45-degree field of view — 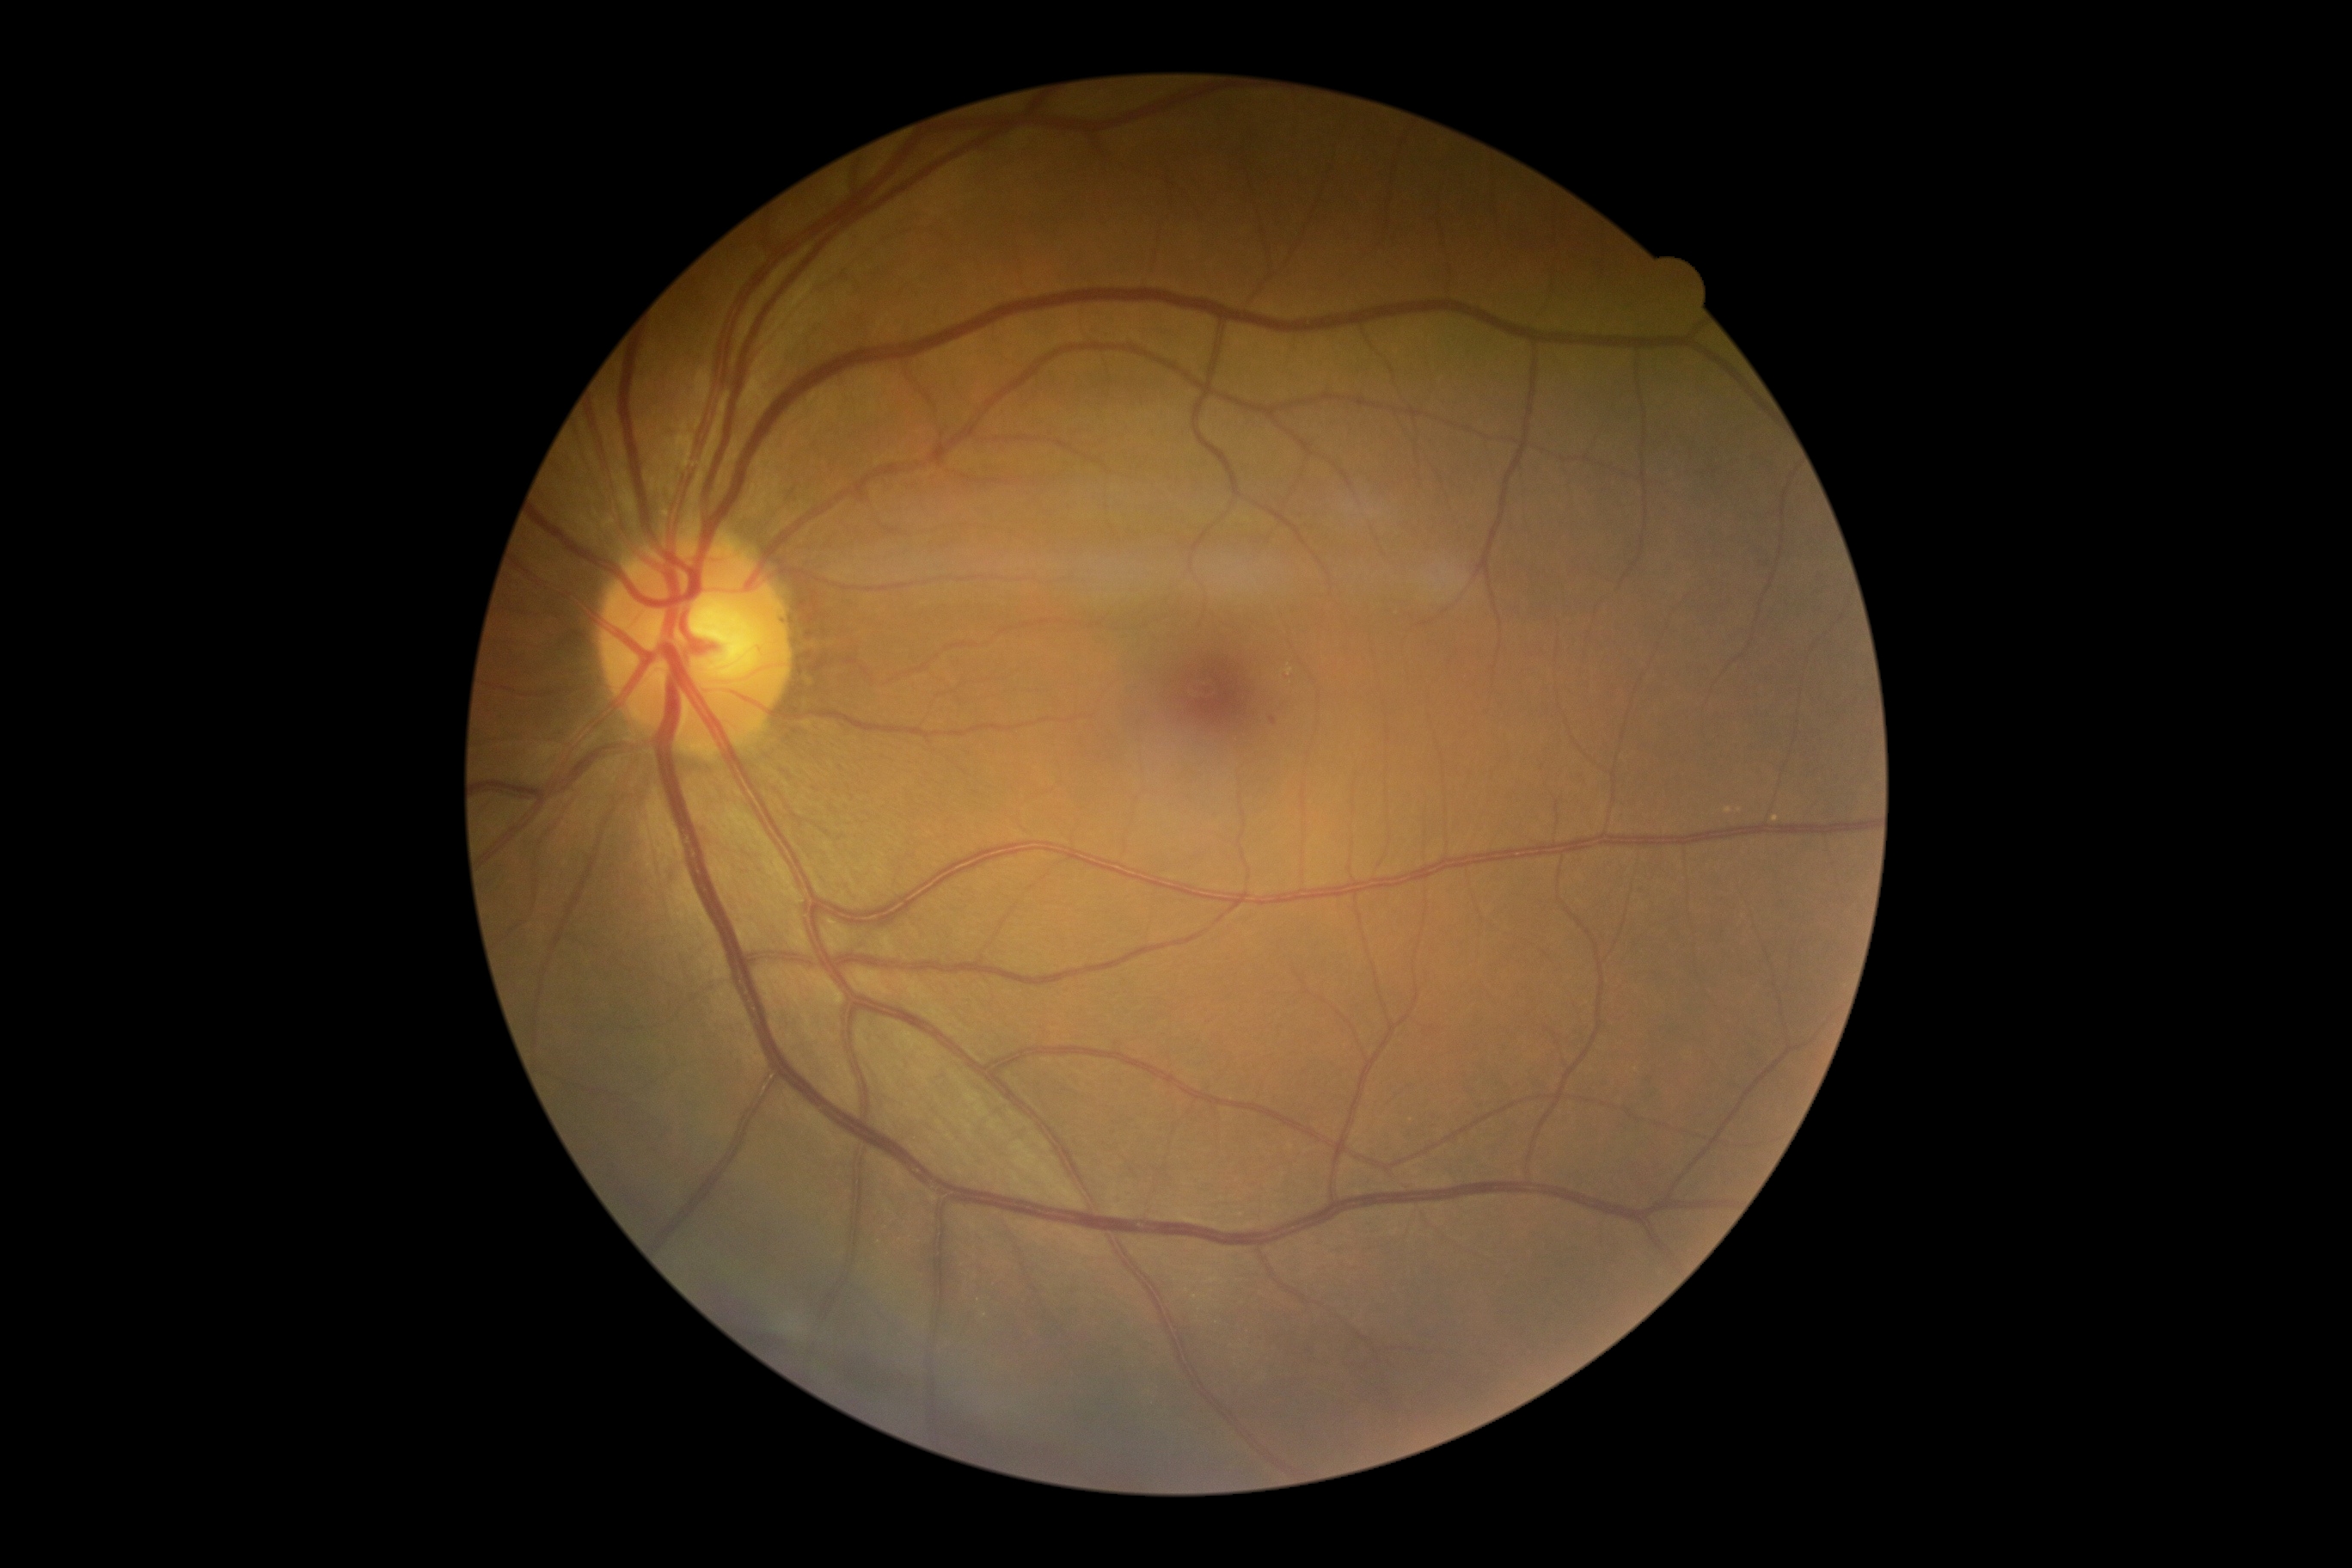 {
  "dr_grade": "mild NPDR (grade 1)",
  "dr_category": "non-proliferative diabetic retinopathy"
}